Without pupil dilation · color fundus photograph — 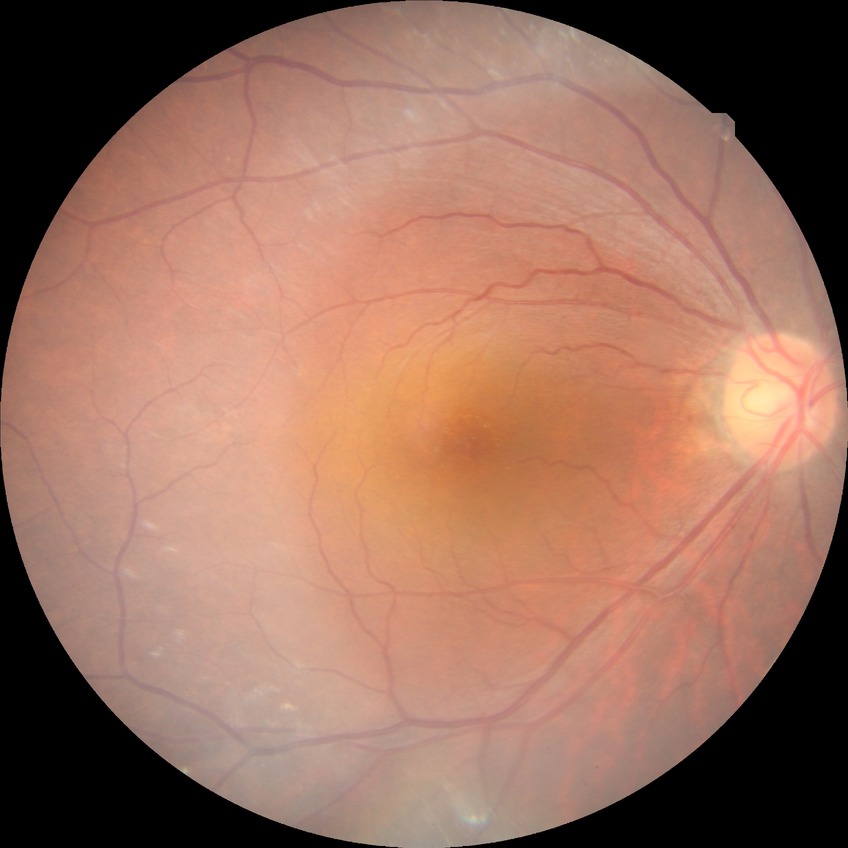 Davis DR grade: NDR.